Acquired with a NIDEK AFC-230 — 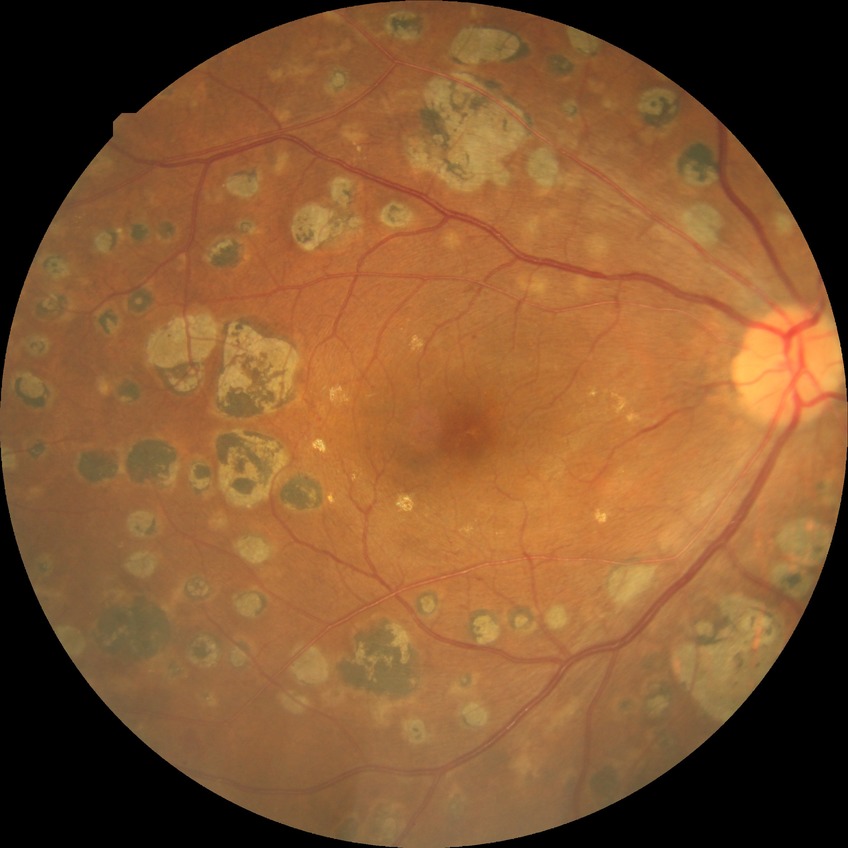
{
  "davis_grade": "proliferative diabetic retinopathy"
}